45-degree field of view
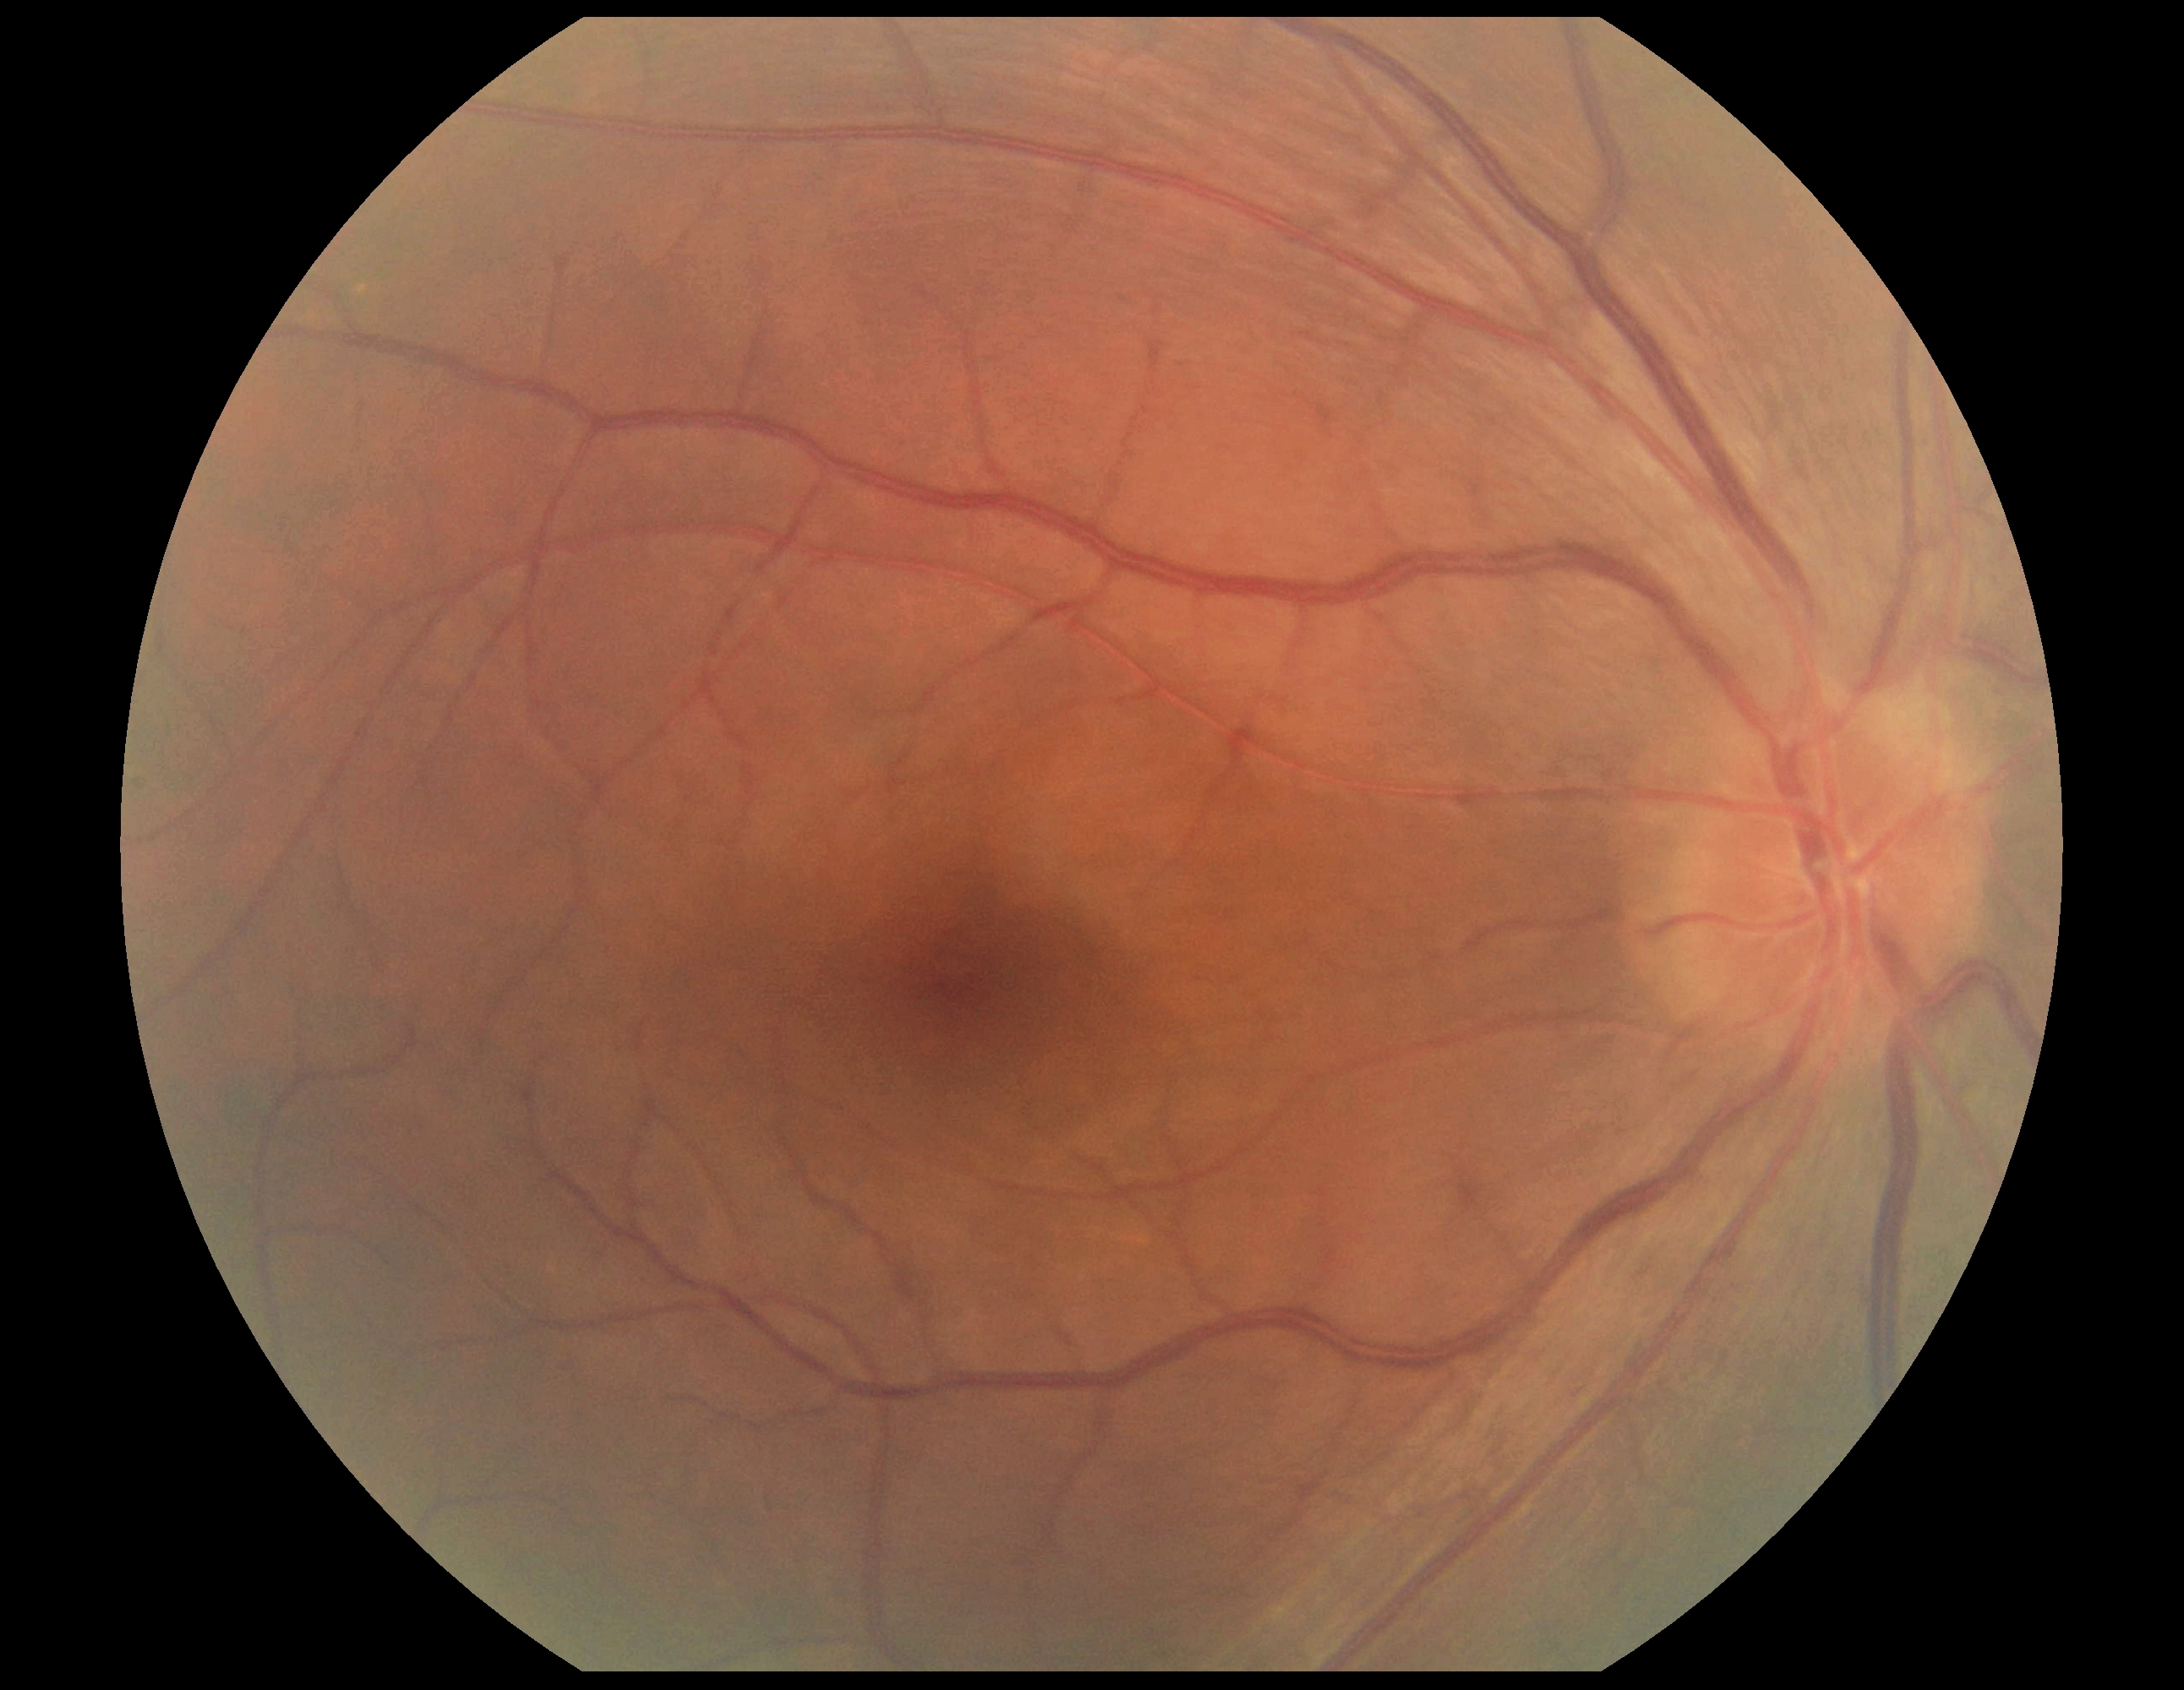

Findings:
* DR impression — no apparent DR
* diabetic retinopathy grade — no apparent diabetic retinopathy (0) — no visible signs of diabetic retinopathy